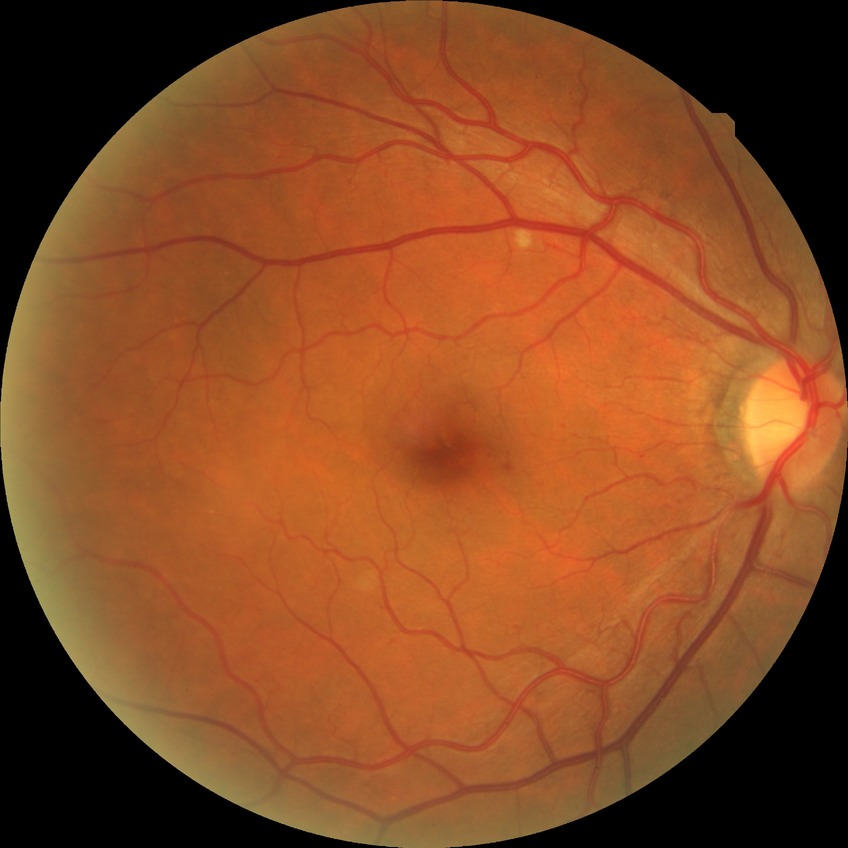

DR grade is SDR.